Retinal fundus photograph.
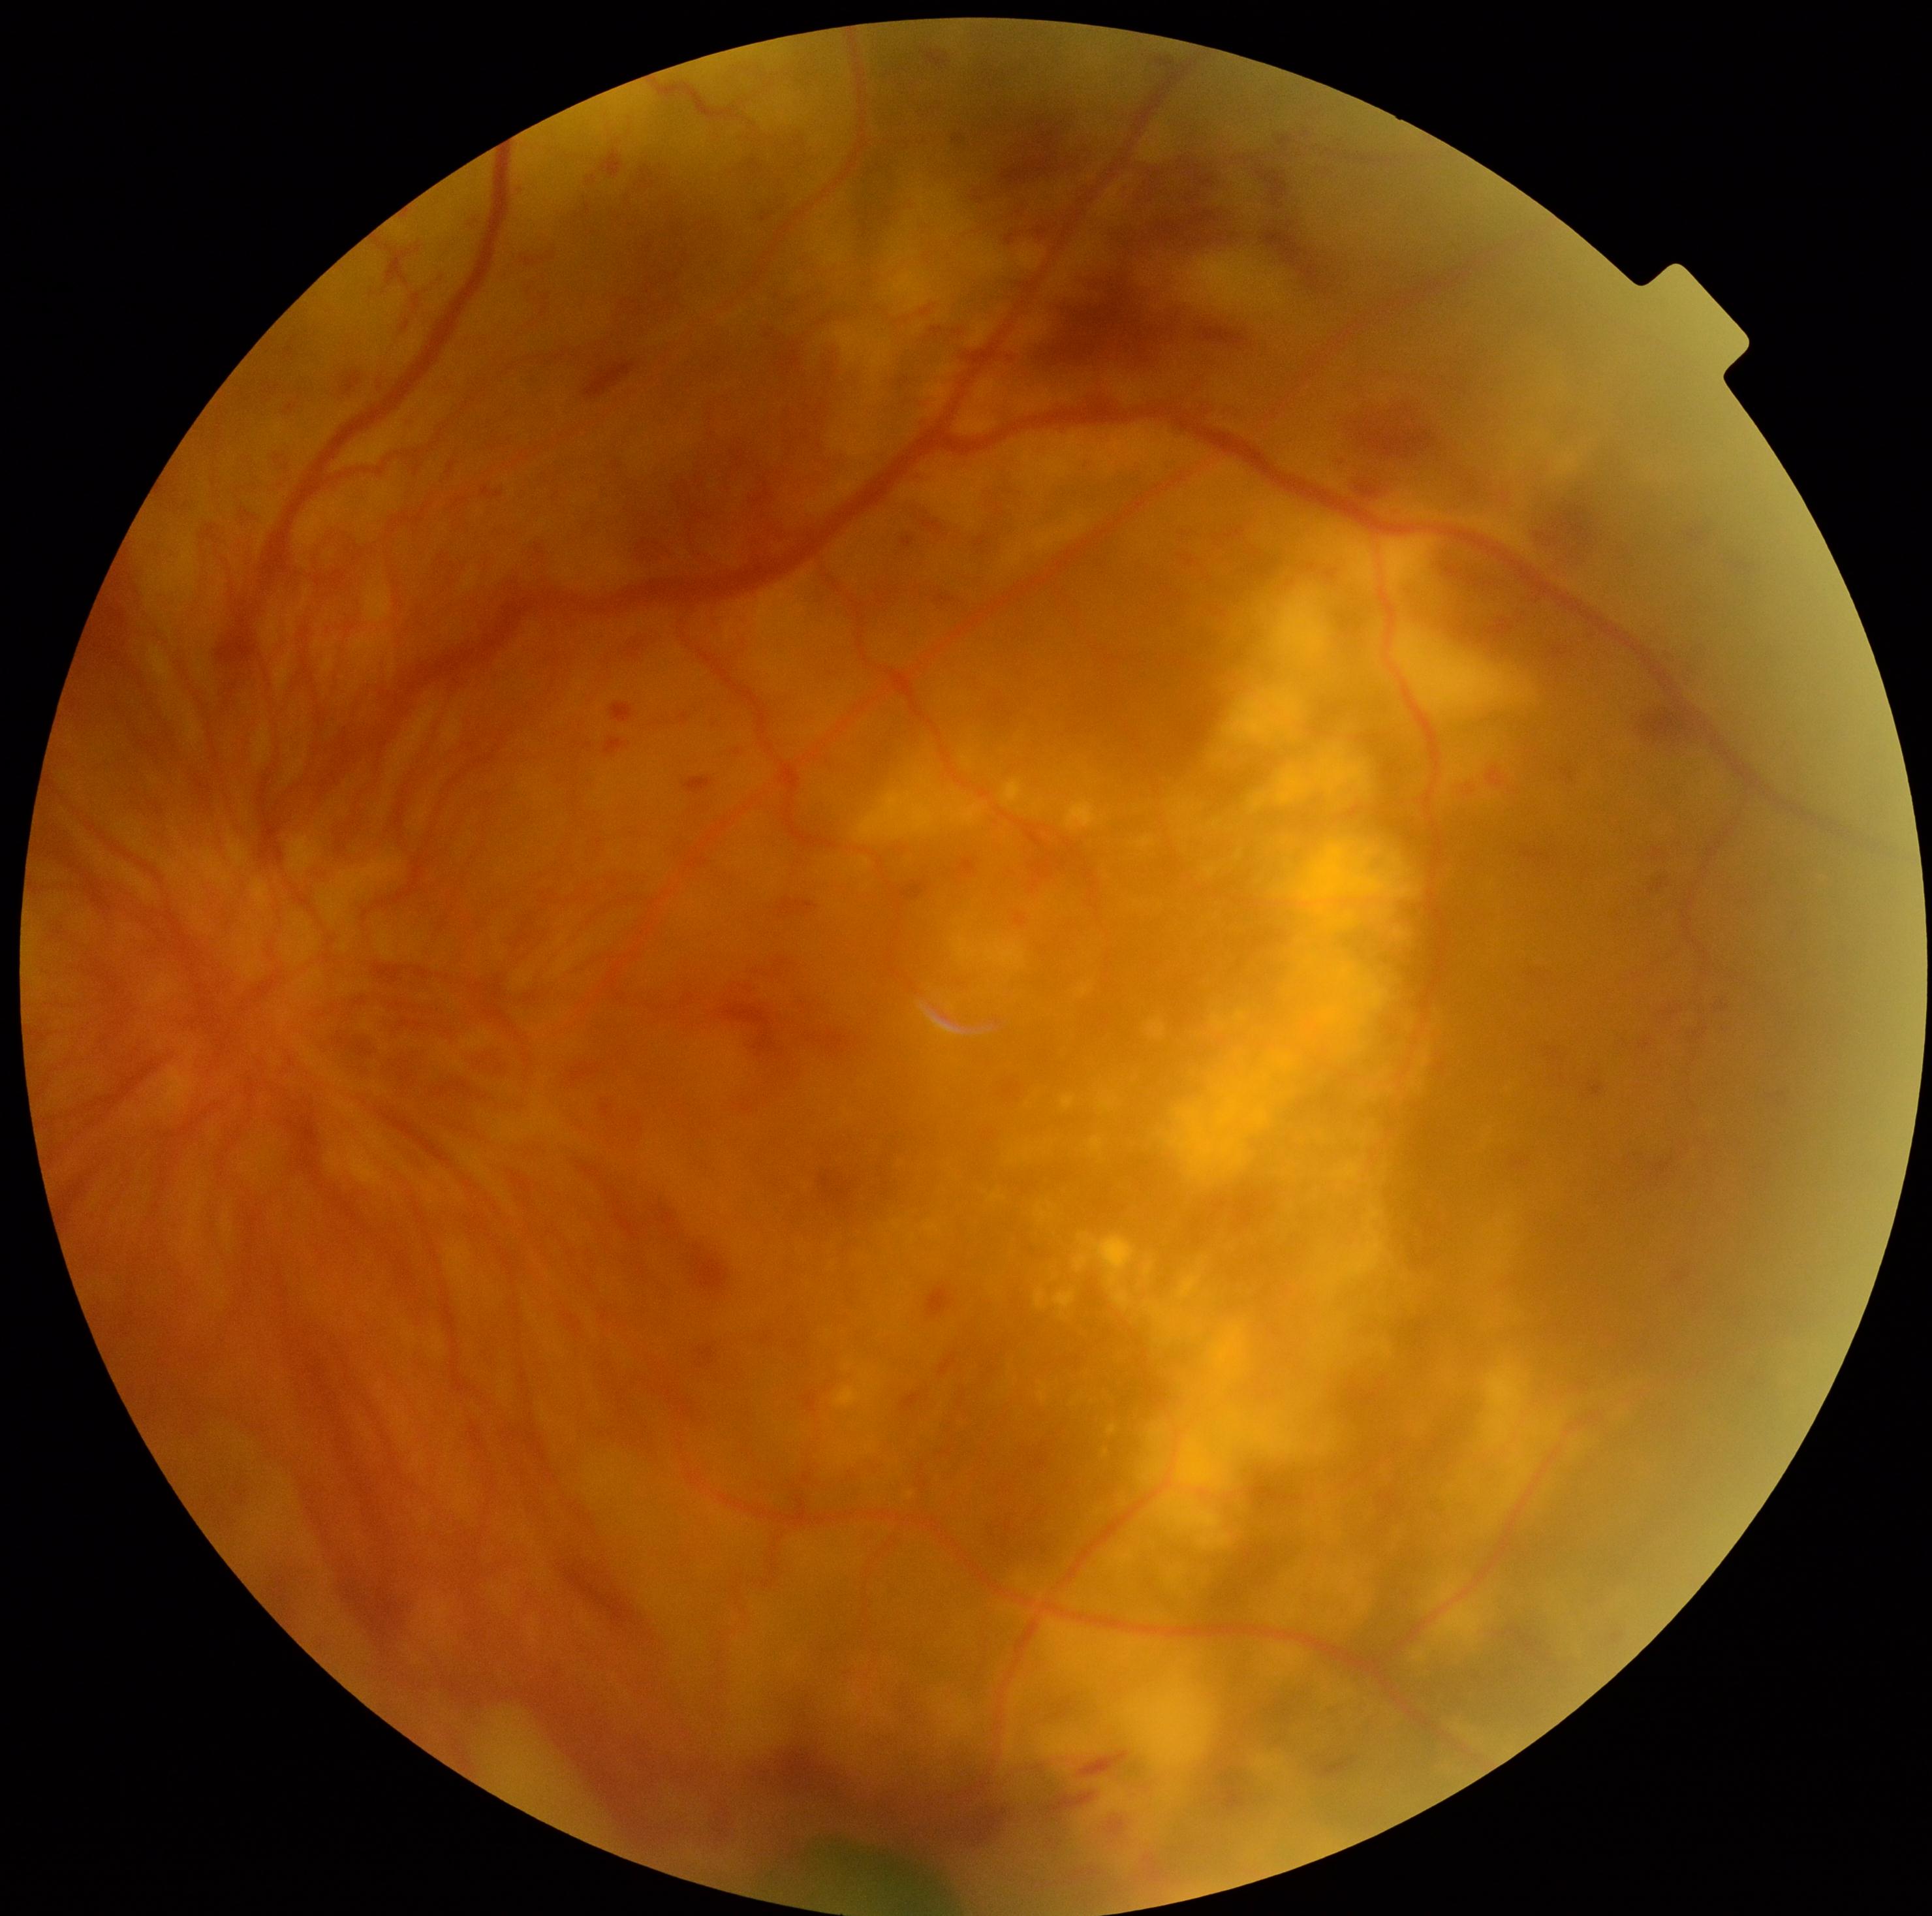
– diabetic retinopathy grade: 4 (PDR)